848x848; color fundus image:
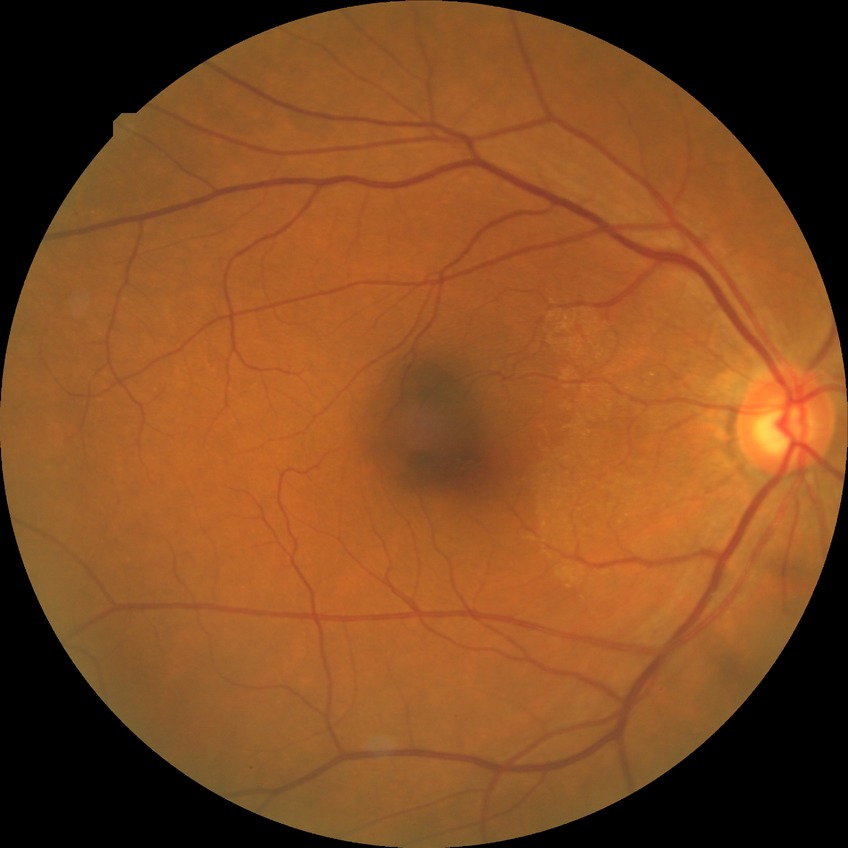 Diabetic retinopathy (DR): NDR (no diabetic retinopathy).